1440 x 1080 pixels. Infant wide-field retinal image: 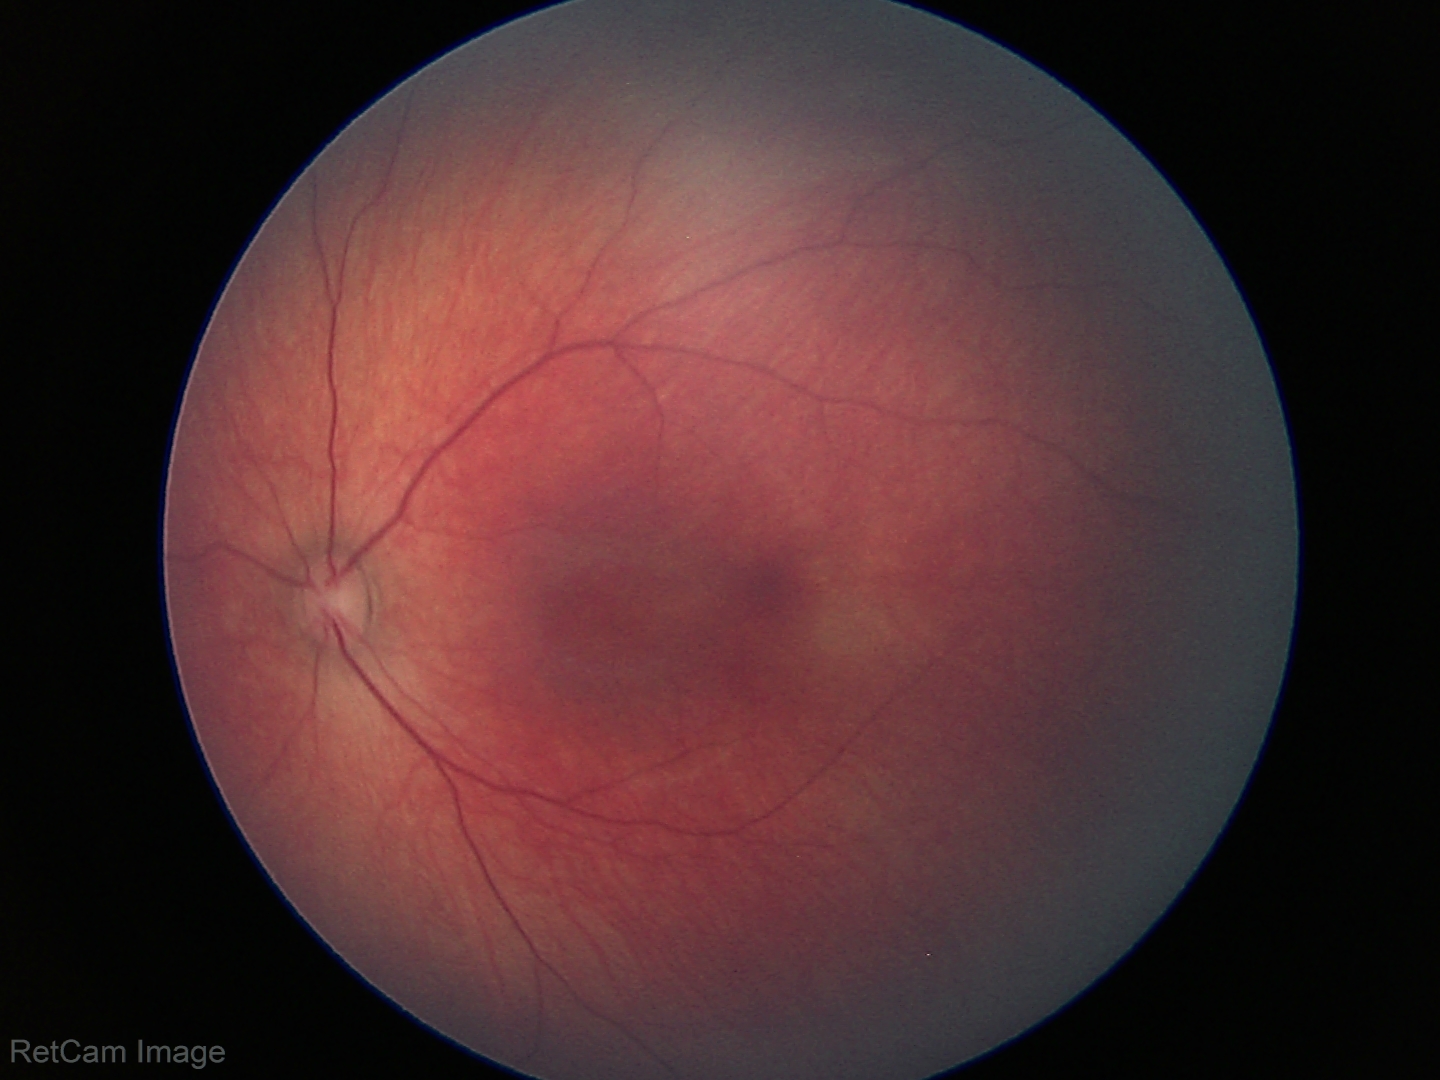

Normal screening examination.